45° FOV.
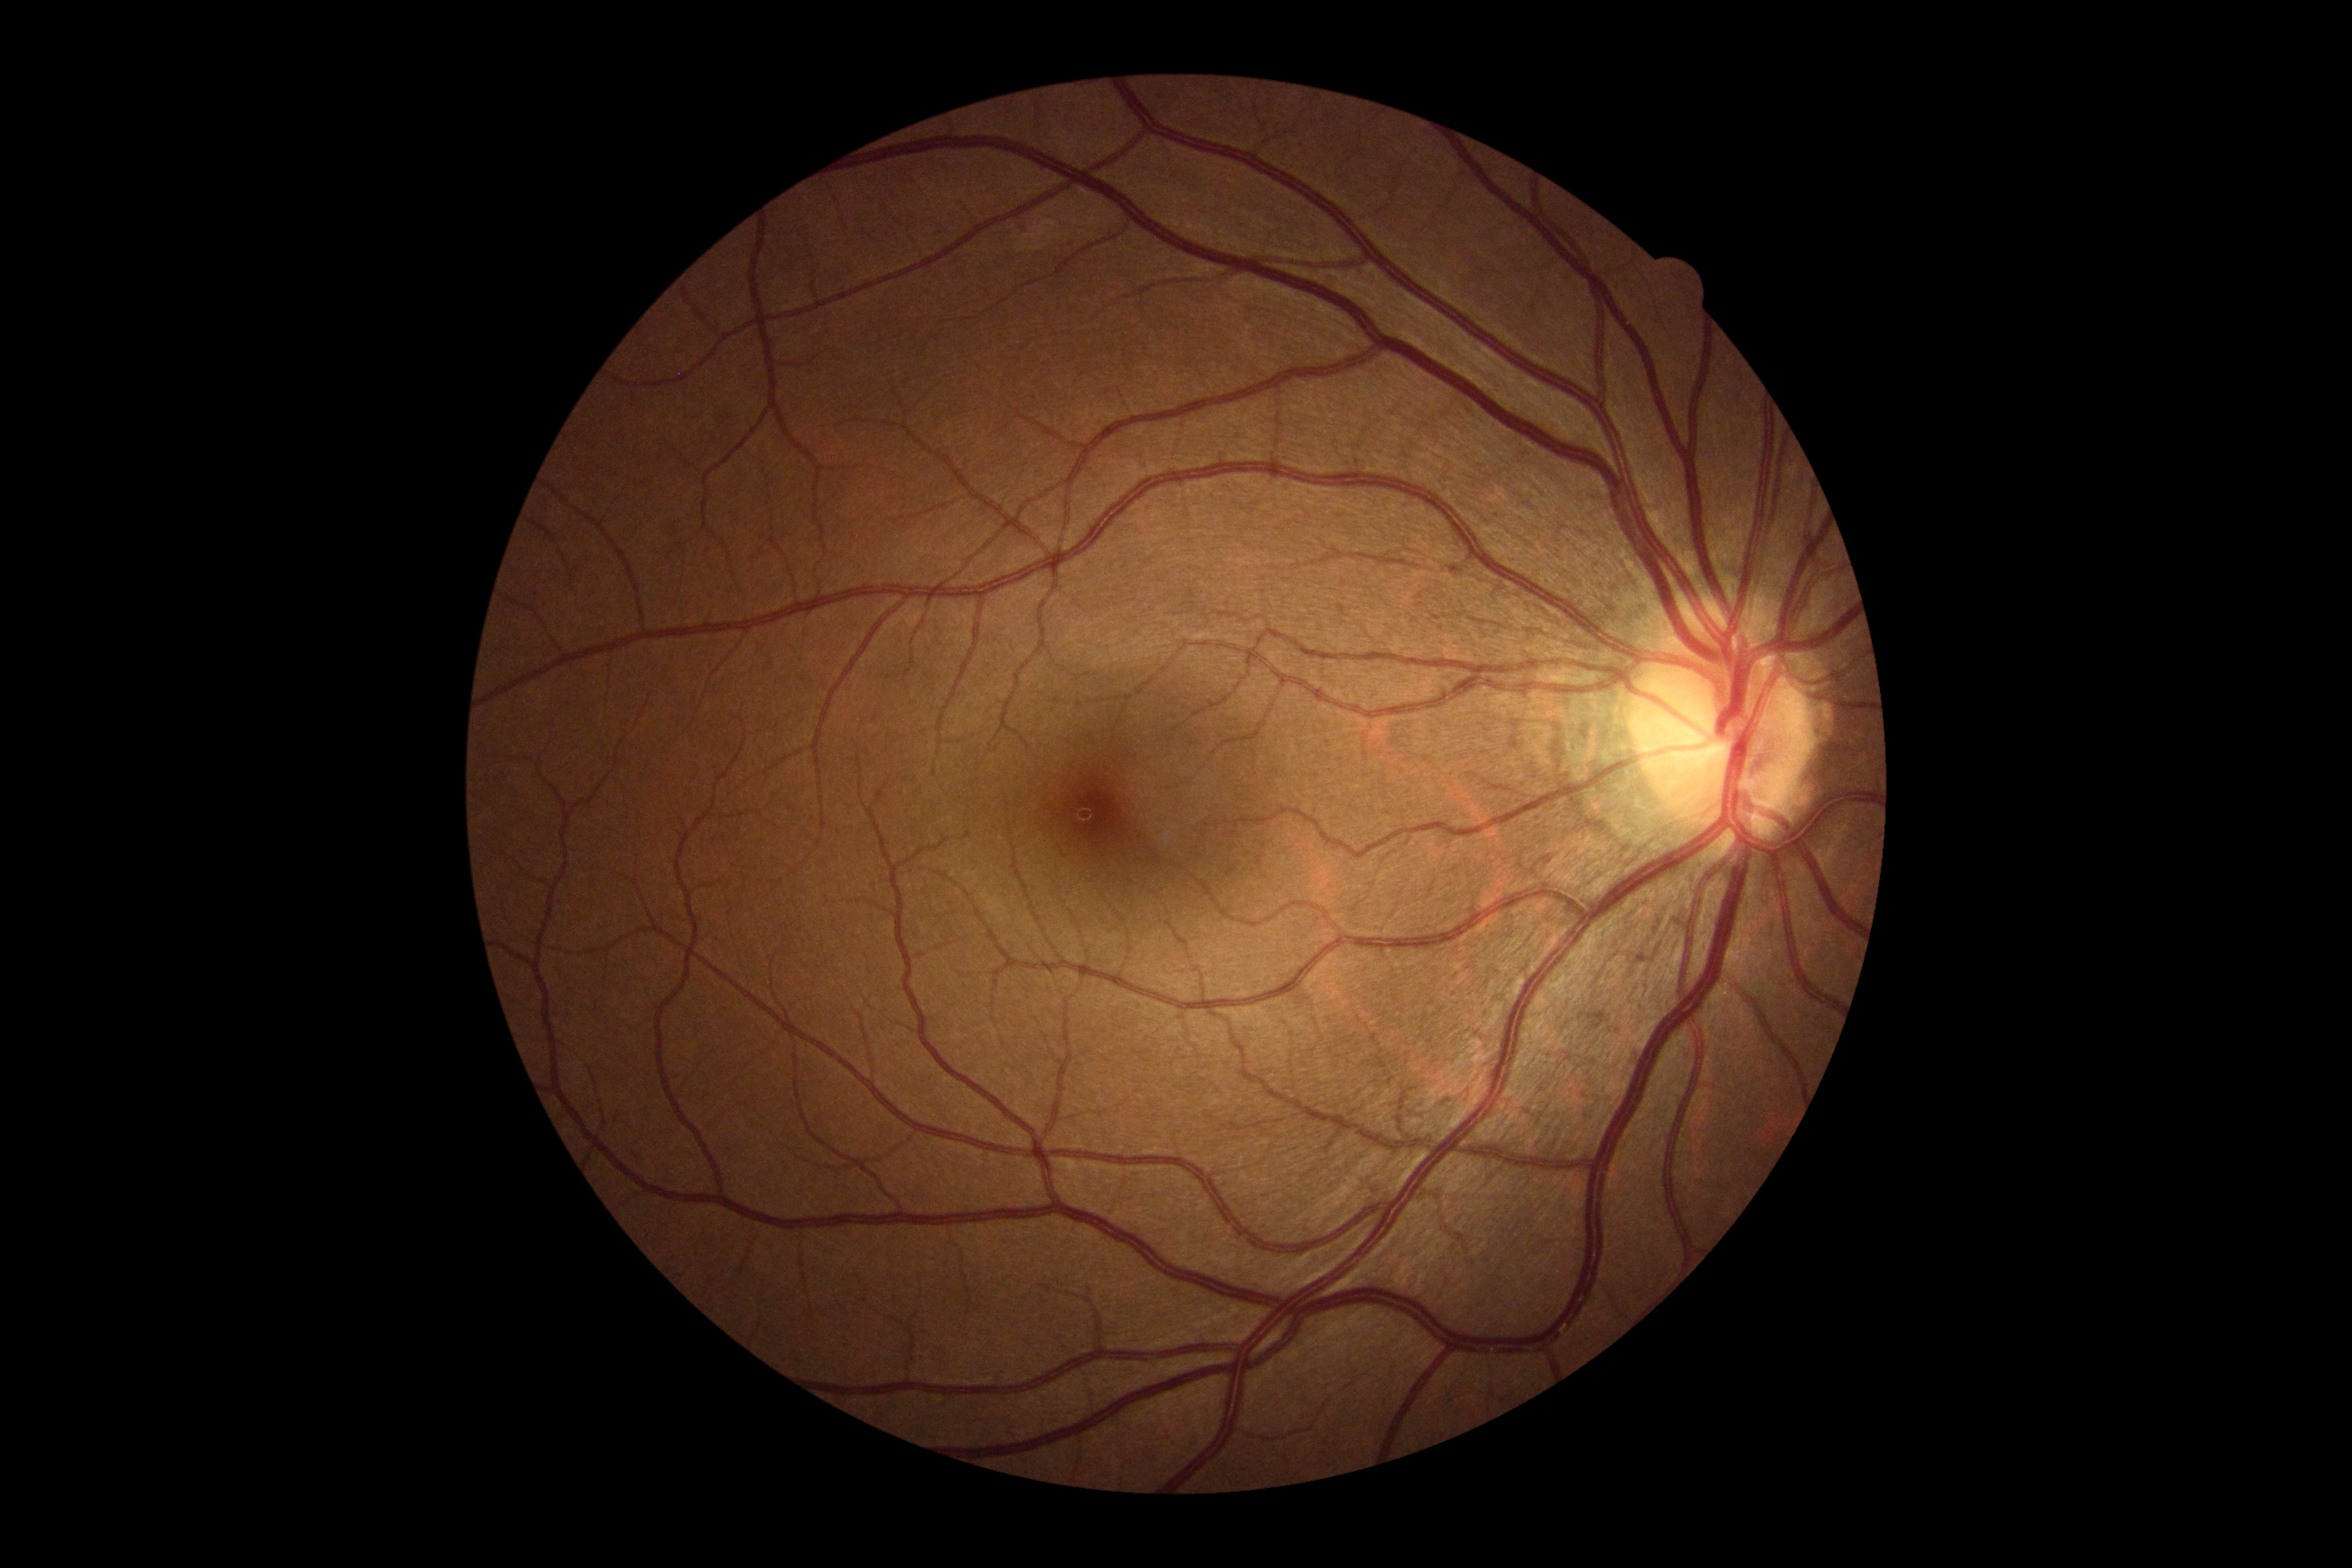 diabetic retinopathy@no apparent diabetic retinopathy (grade 0), DR impression@no signs of DR.